Color fundus photograph · 1536x1152
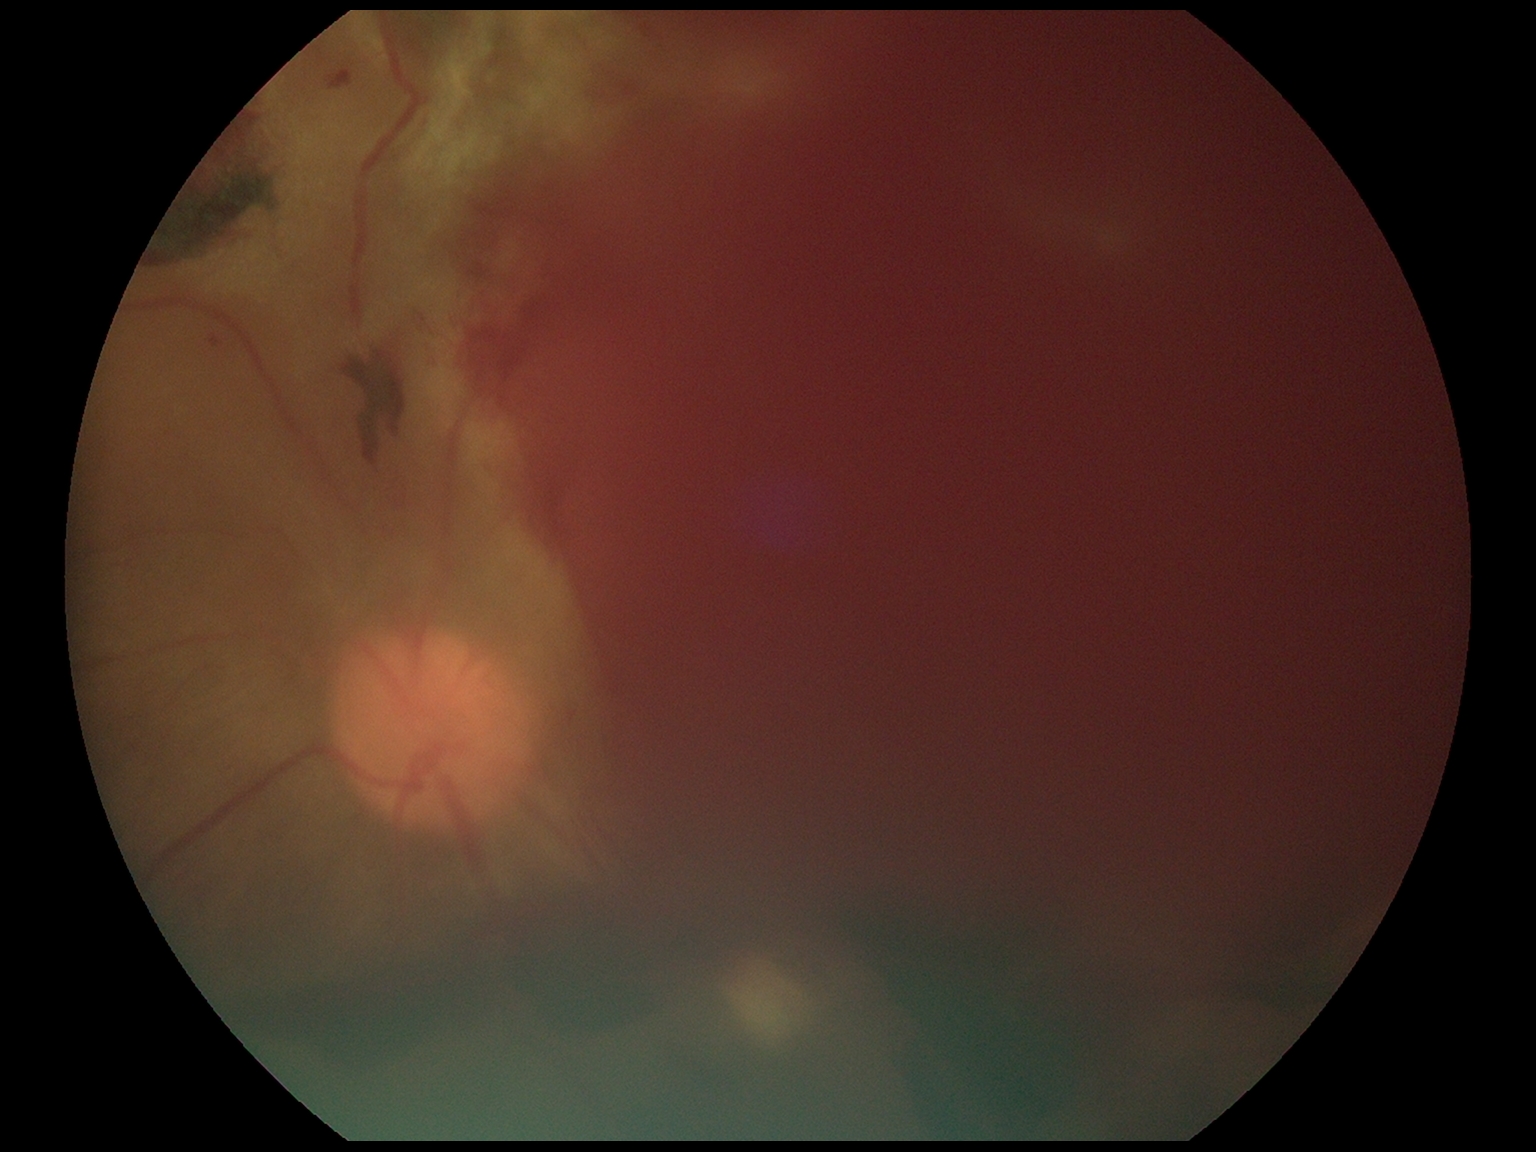 DR class = proliferative diabetic retinopathy, diabetic retinopathy grade = 4/4.